FOV: 45 degrees
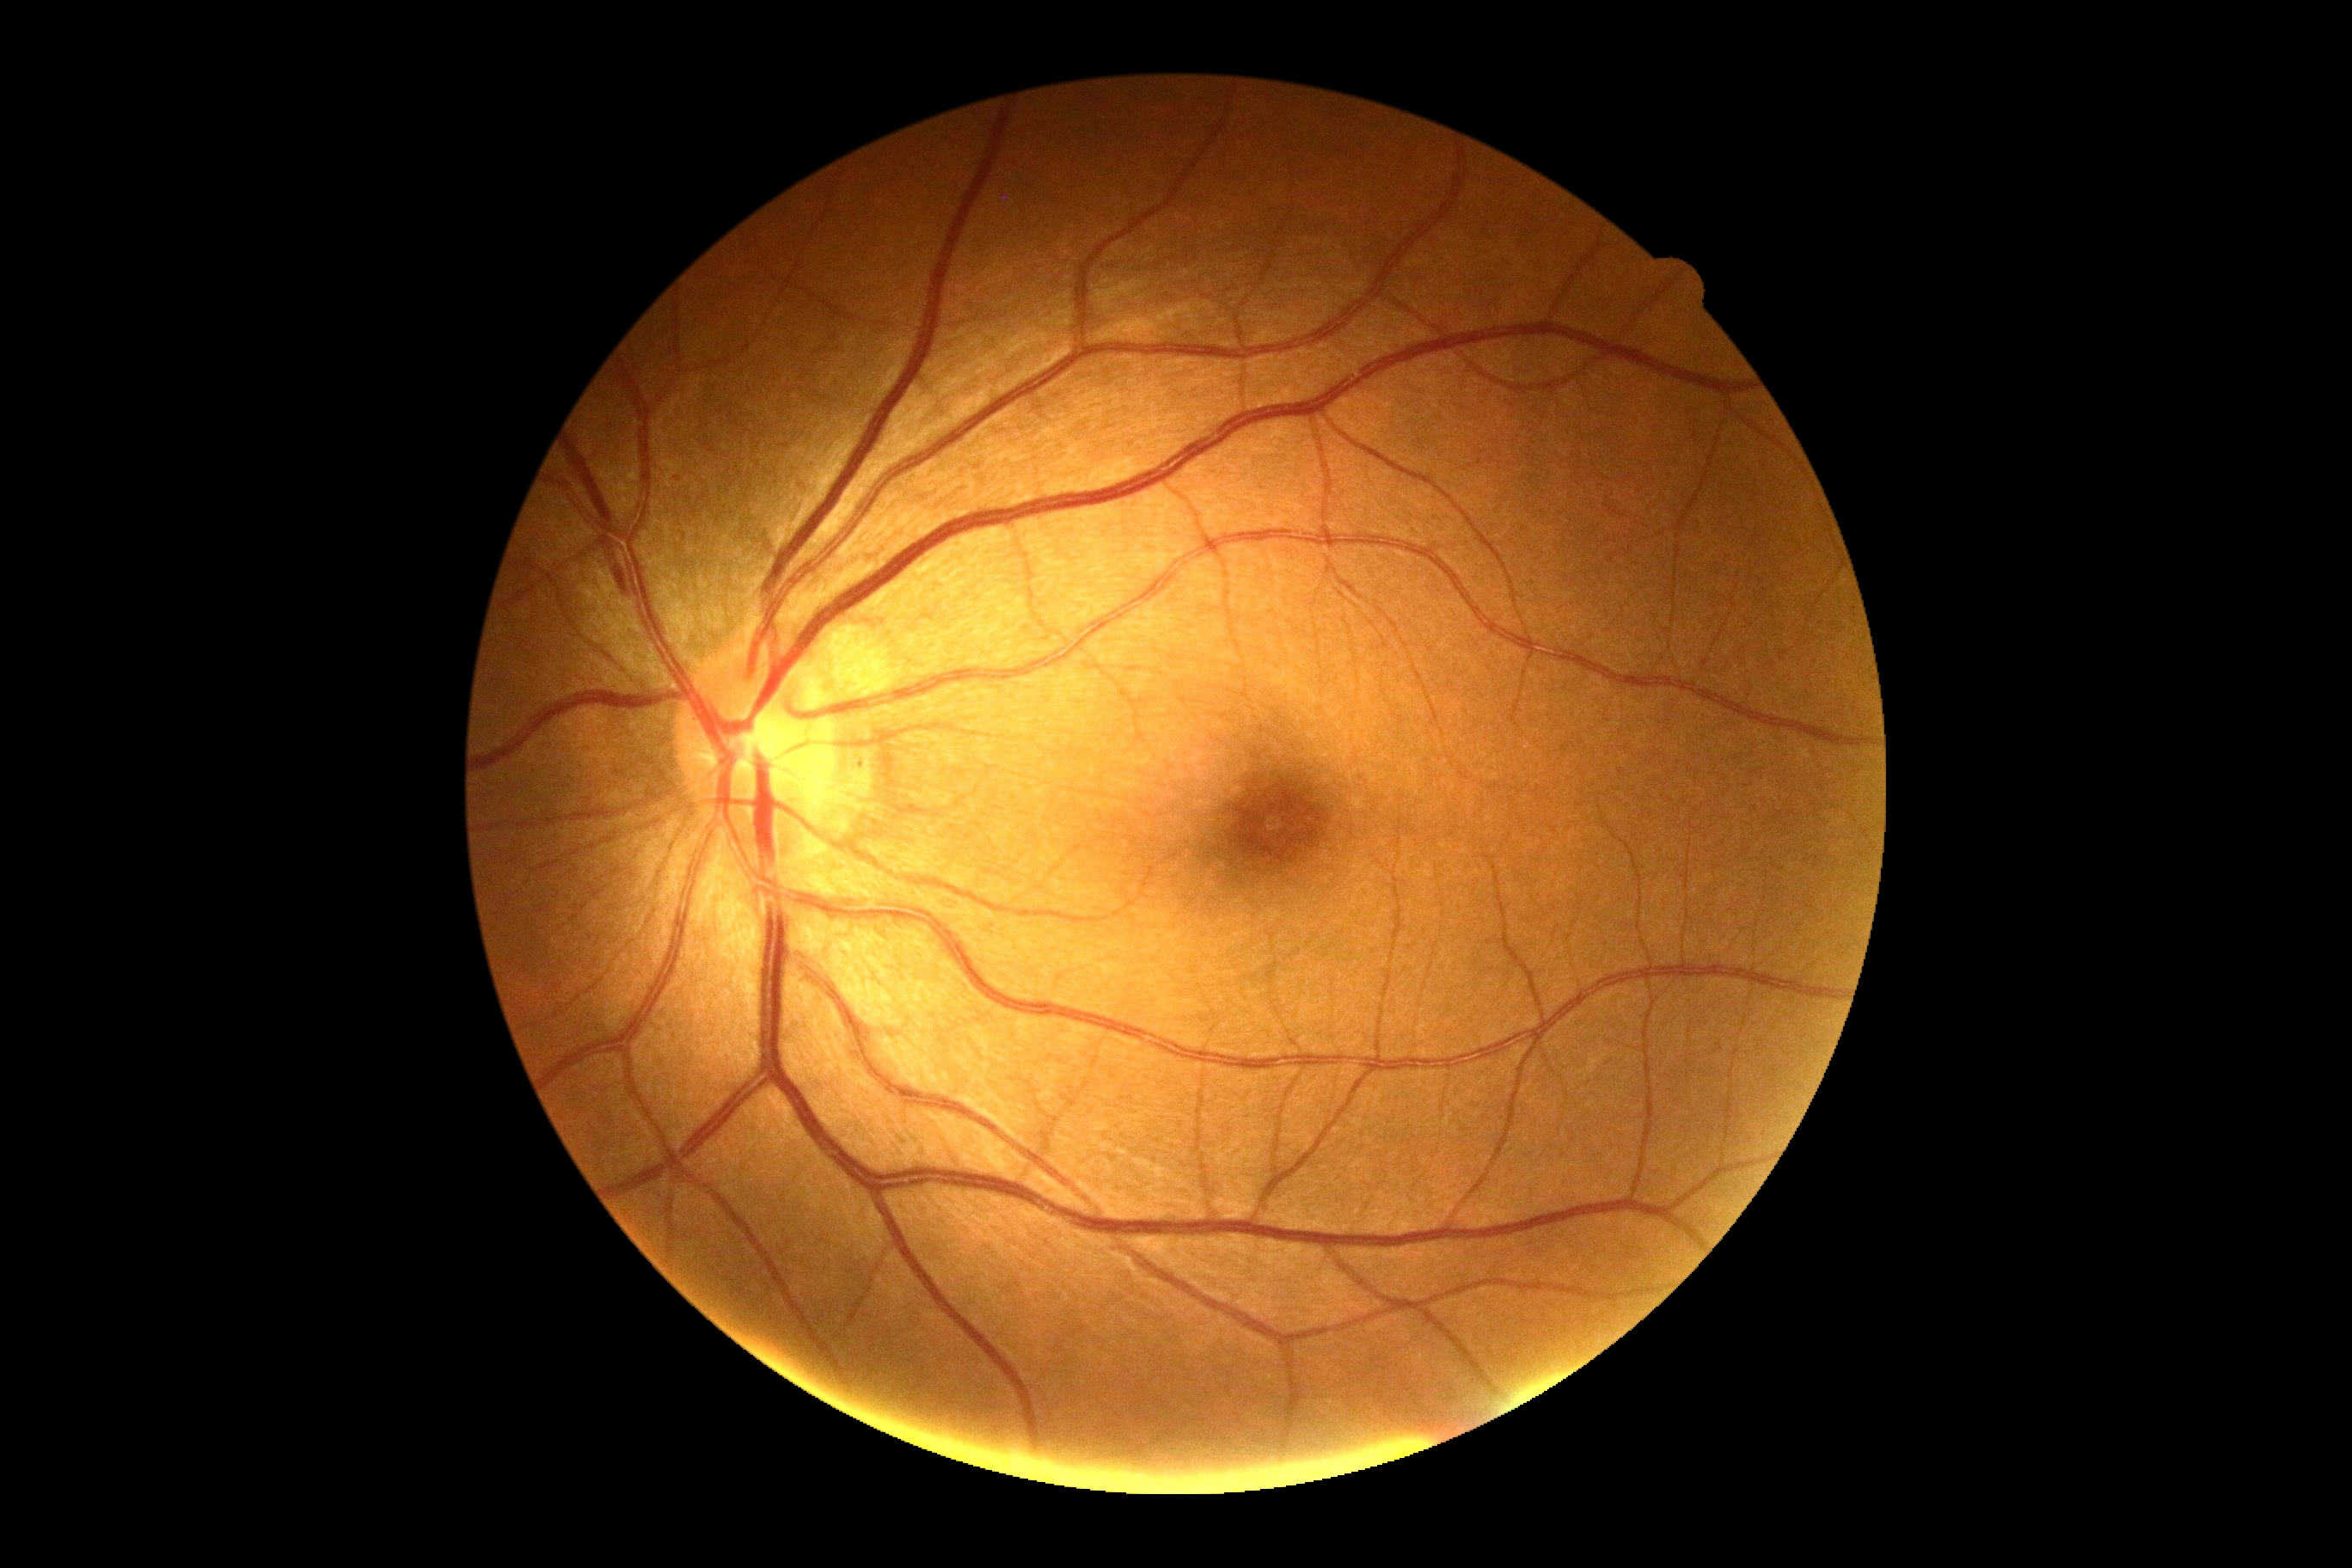 {"dr_grade": "grade 0 (no apparent retinopathy) — no visible signs of diabetic retinopathy"}